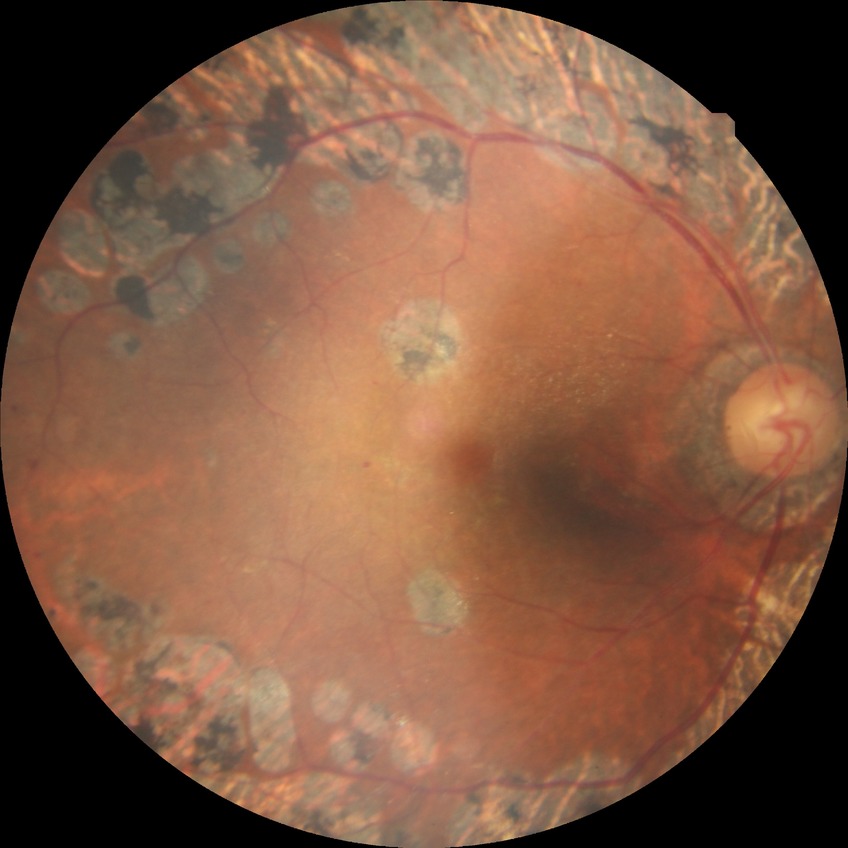 Retinopathy stage: proliferative diabetic retinopathy.